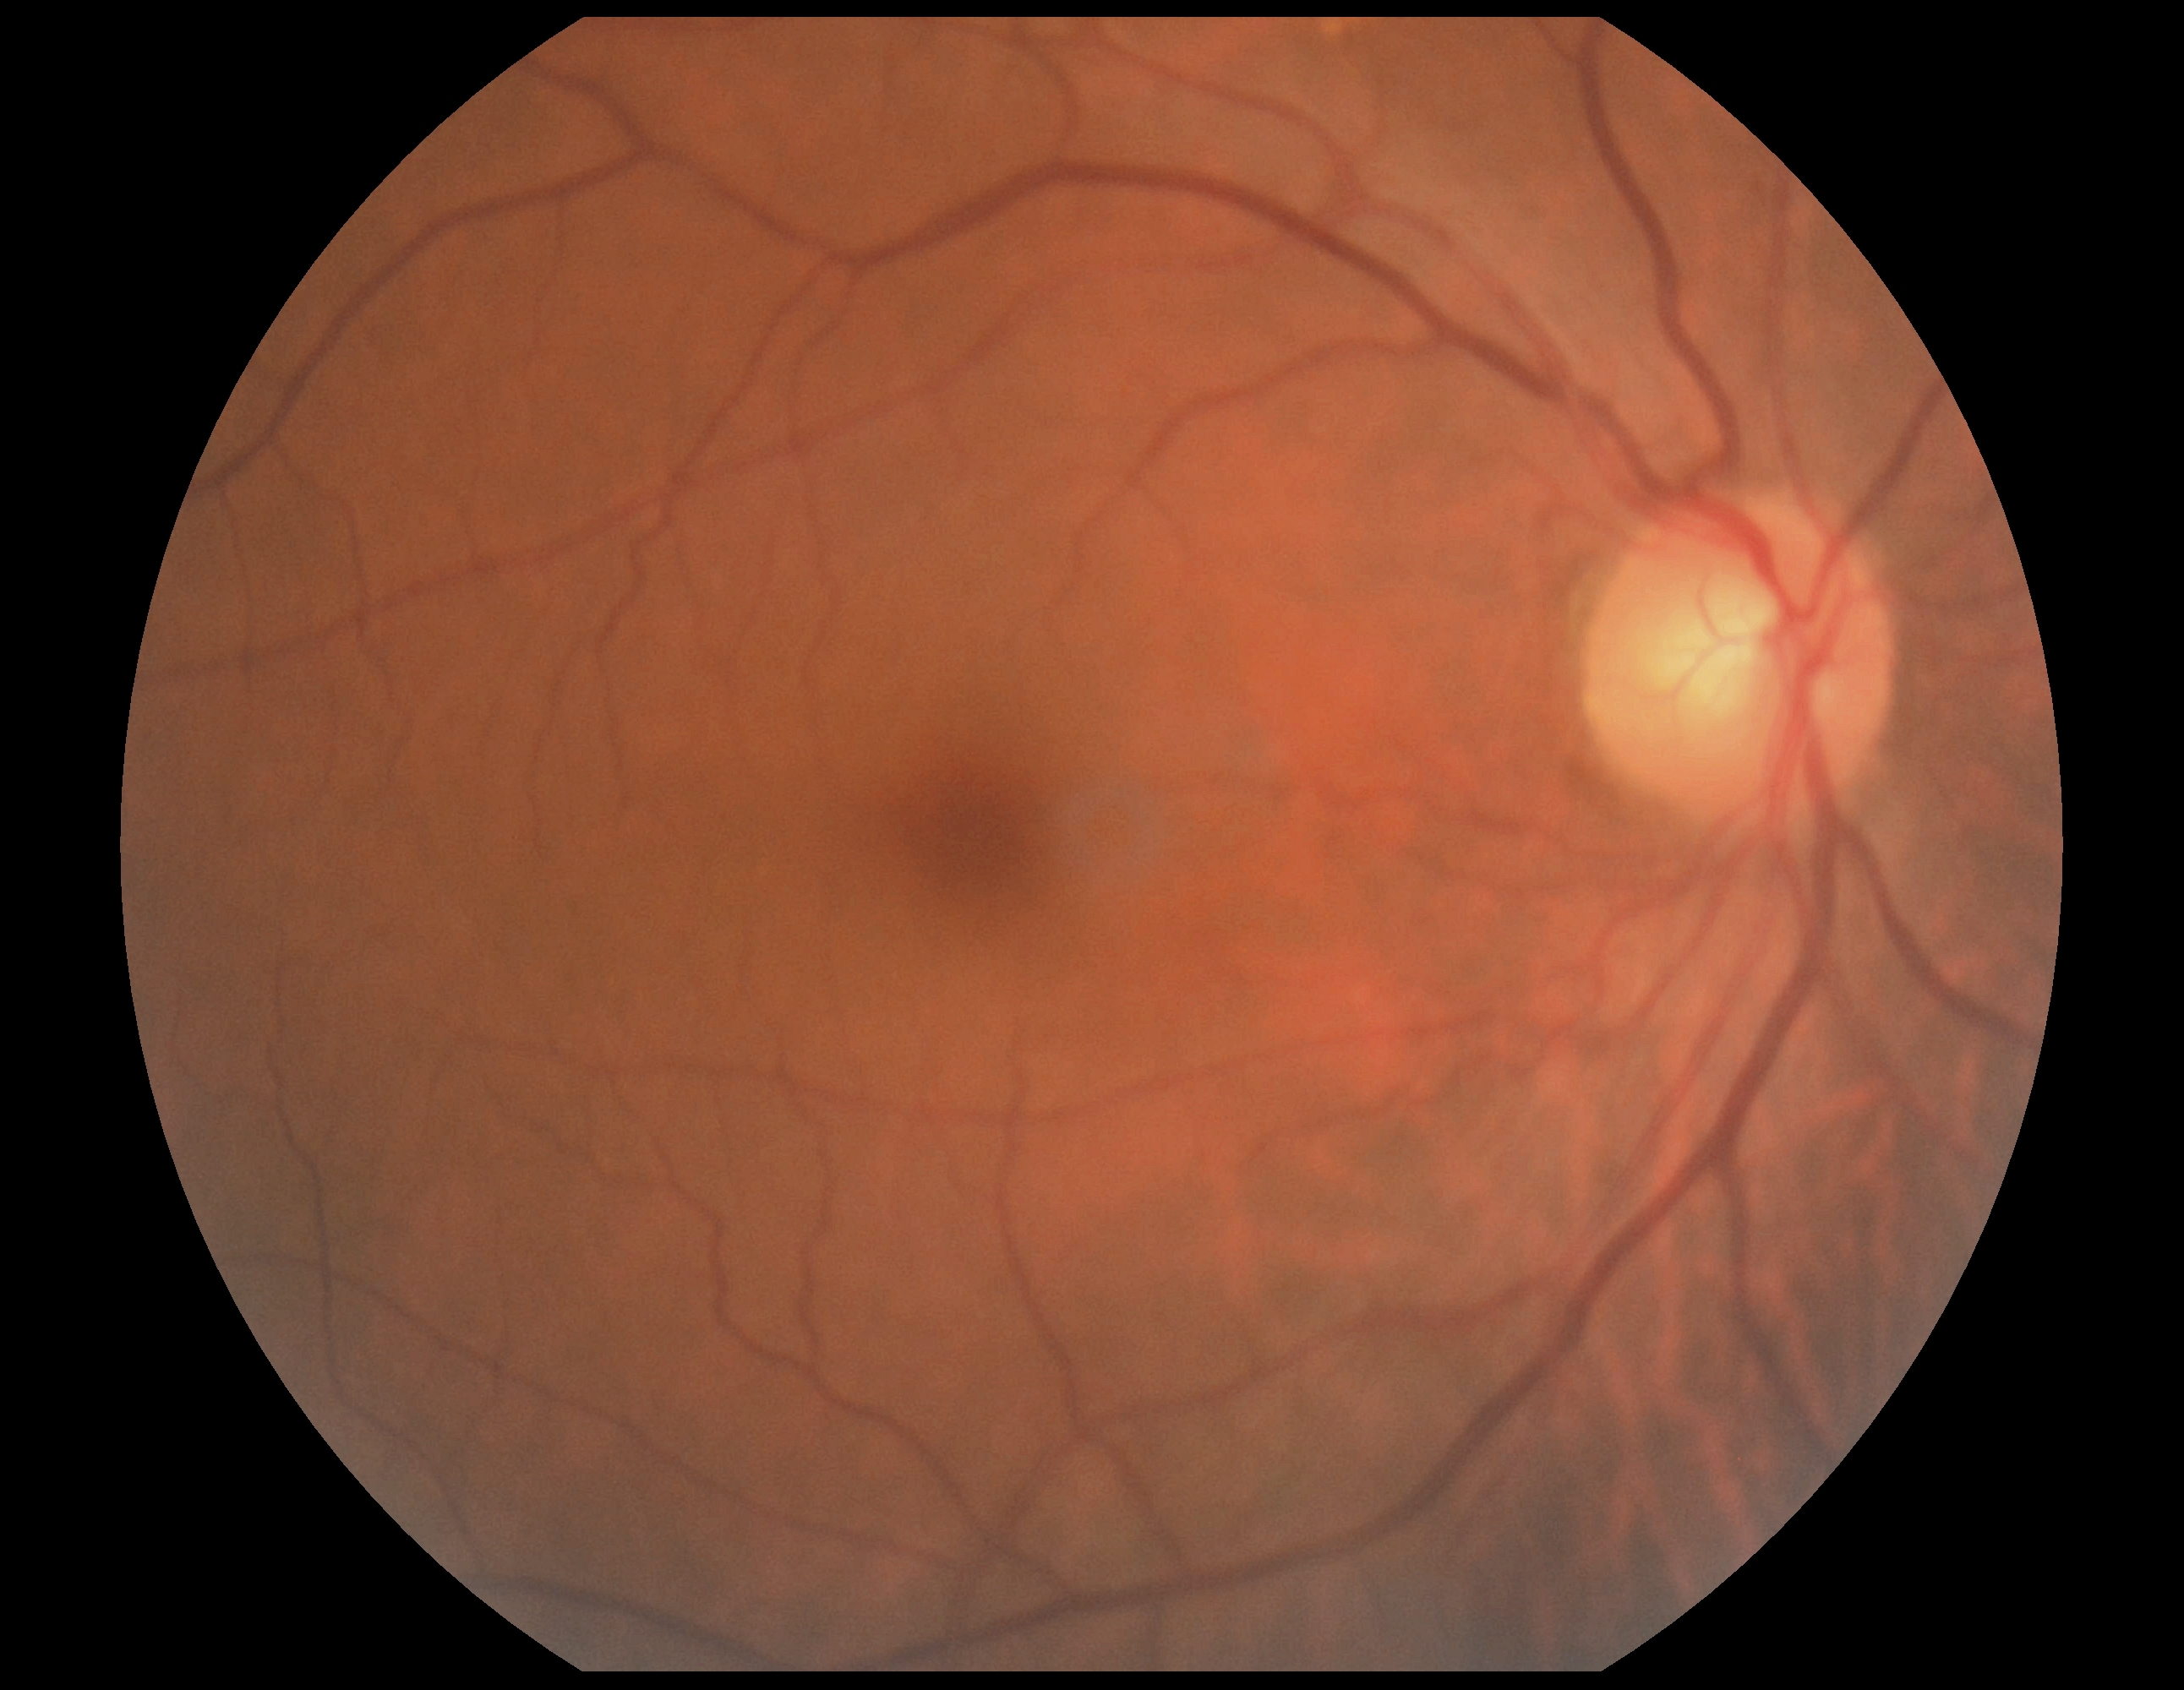
dr_impression: no apparent DR
dr_grade: no apparent retinopathy (0) — no visible signs of diabetic retinopathy